Optic disc-centered crop from a color fundus photograph:
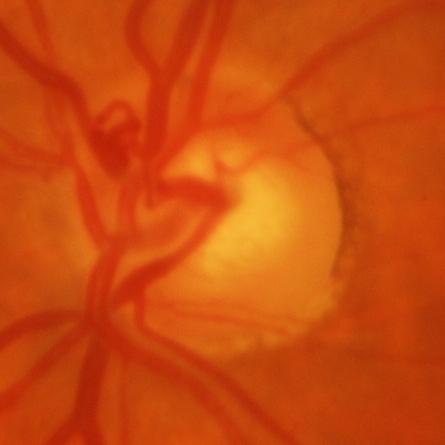
Glaucomatous optic neuropathy is present.
Evidence of glaucoma.